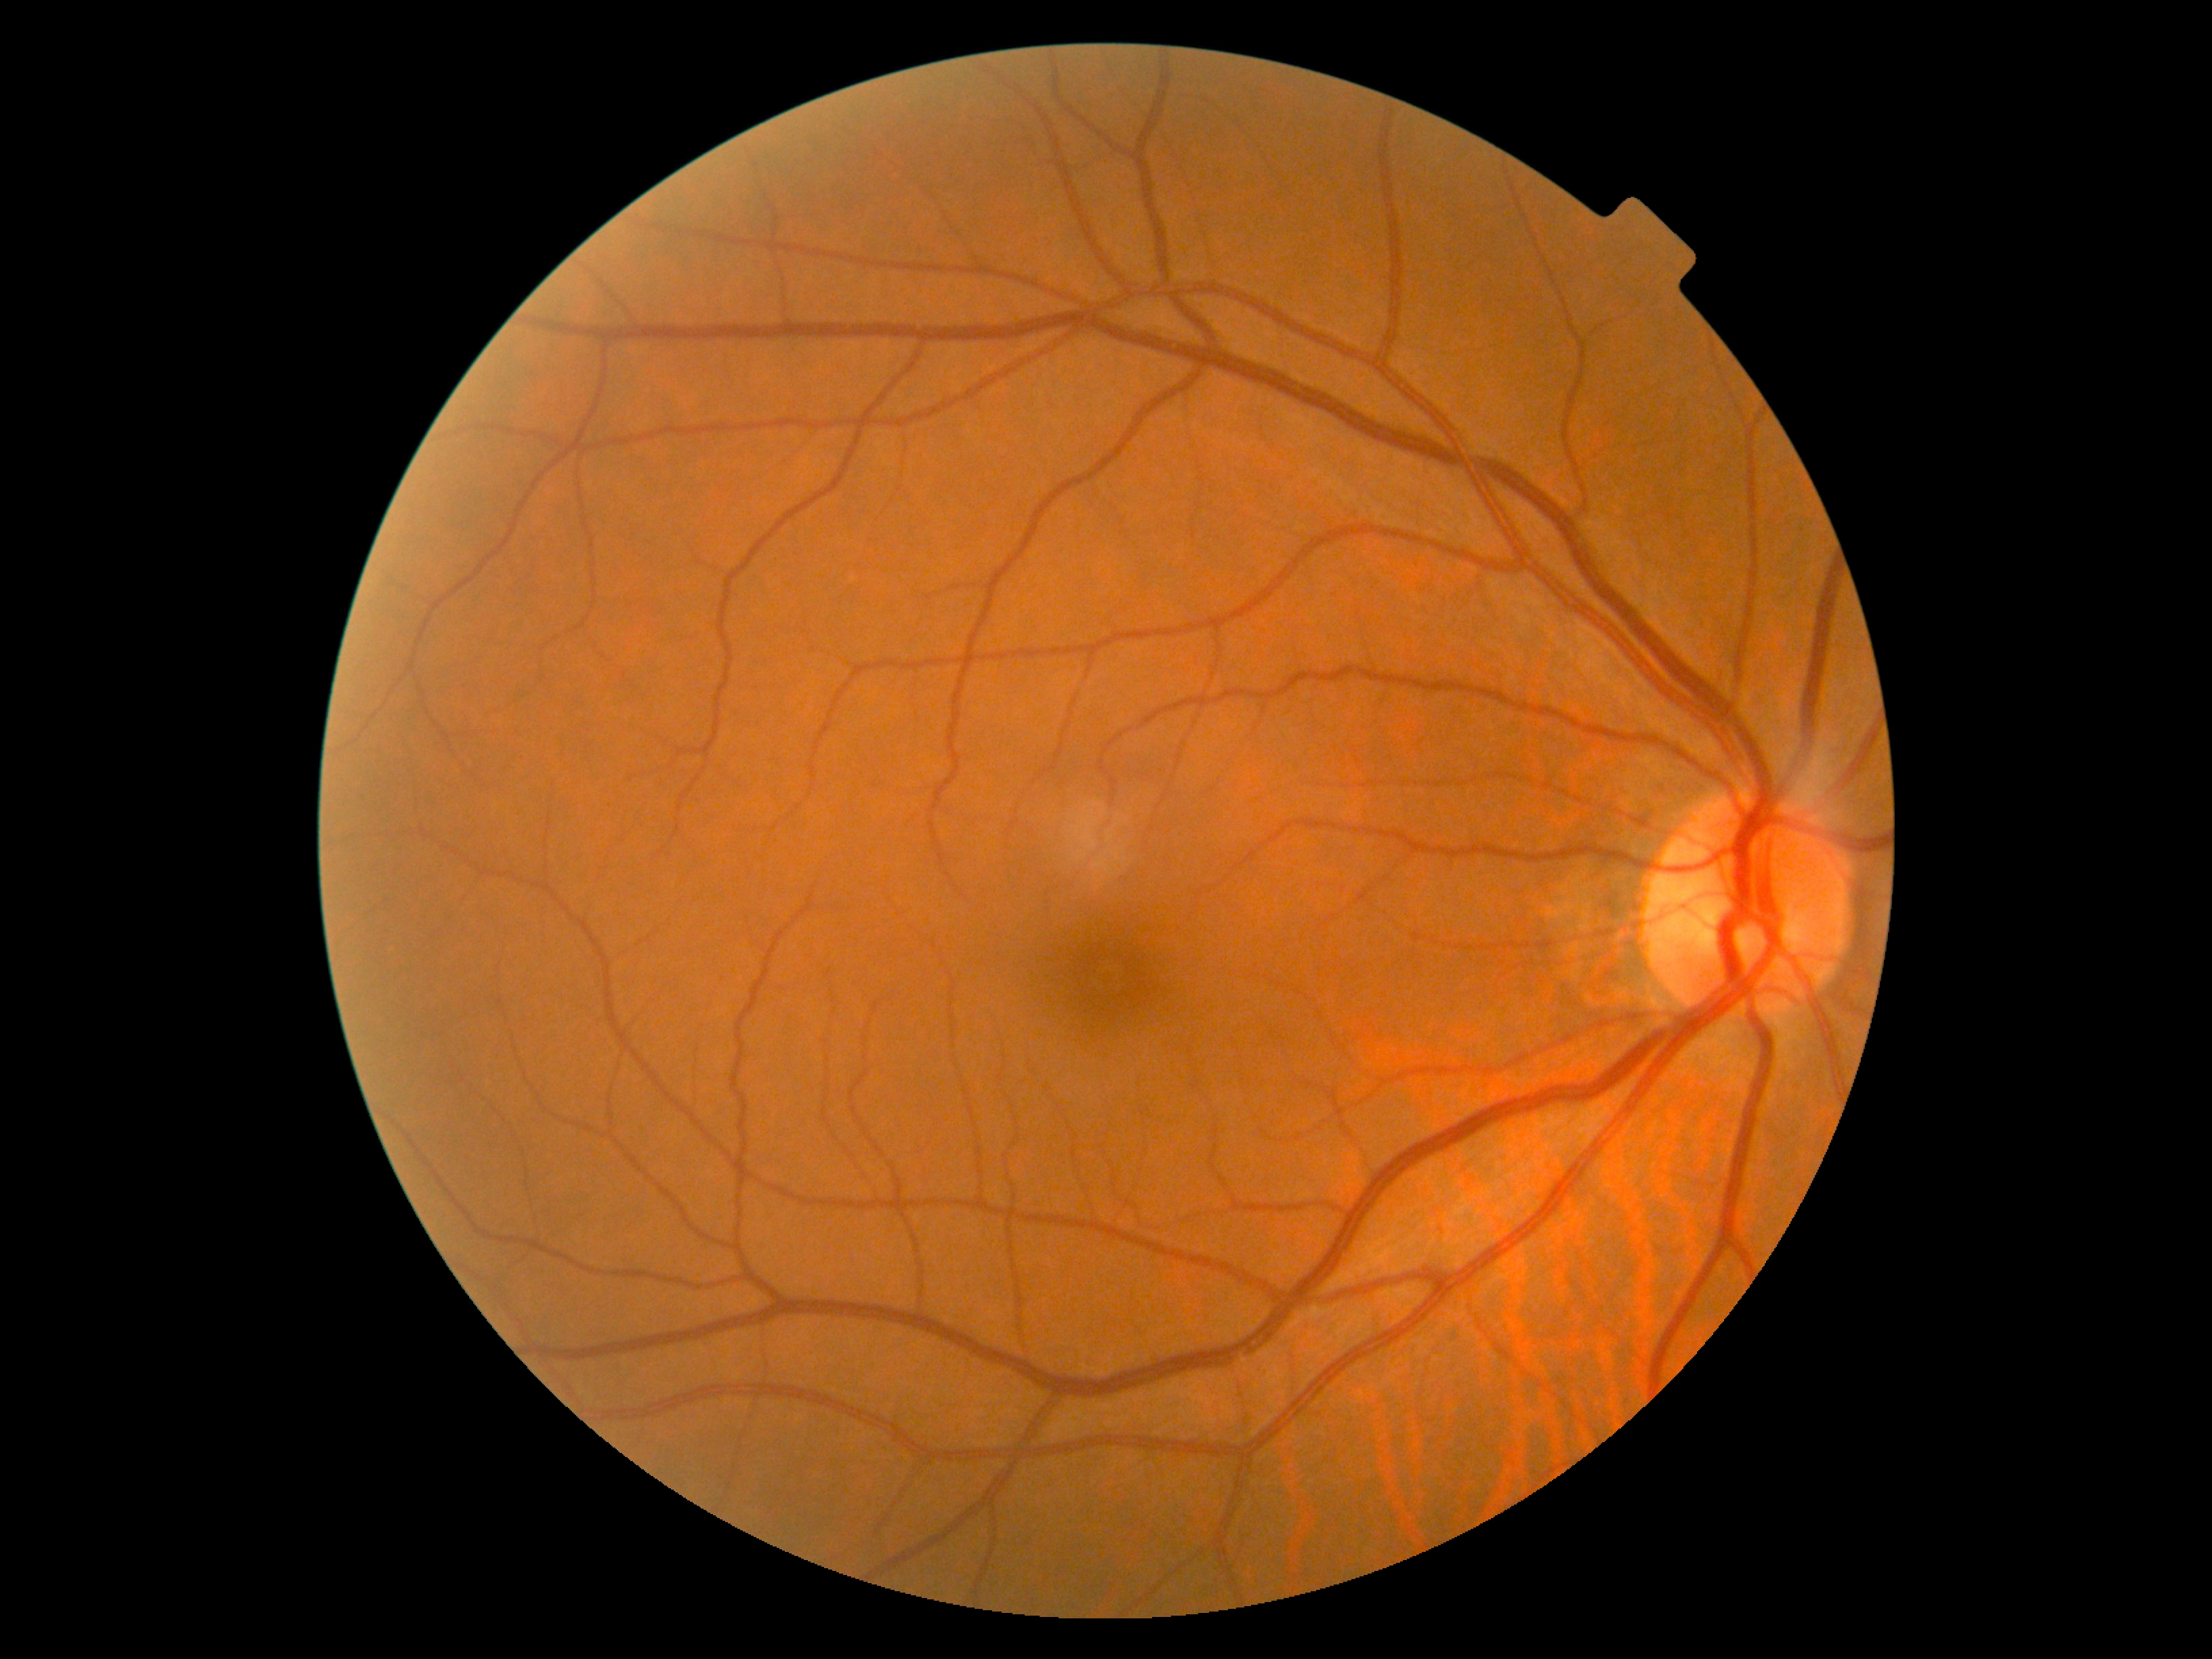 Retinopathy grade is 0/4.